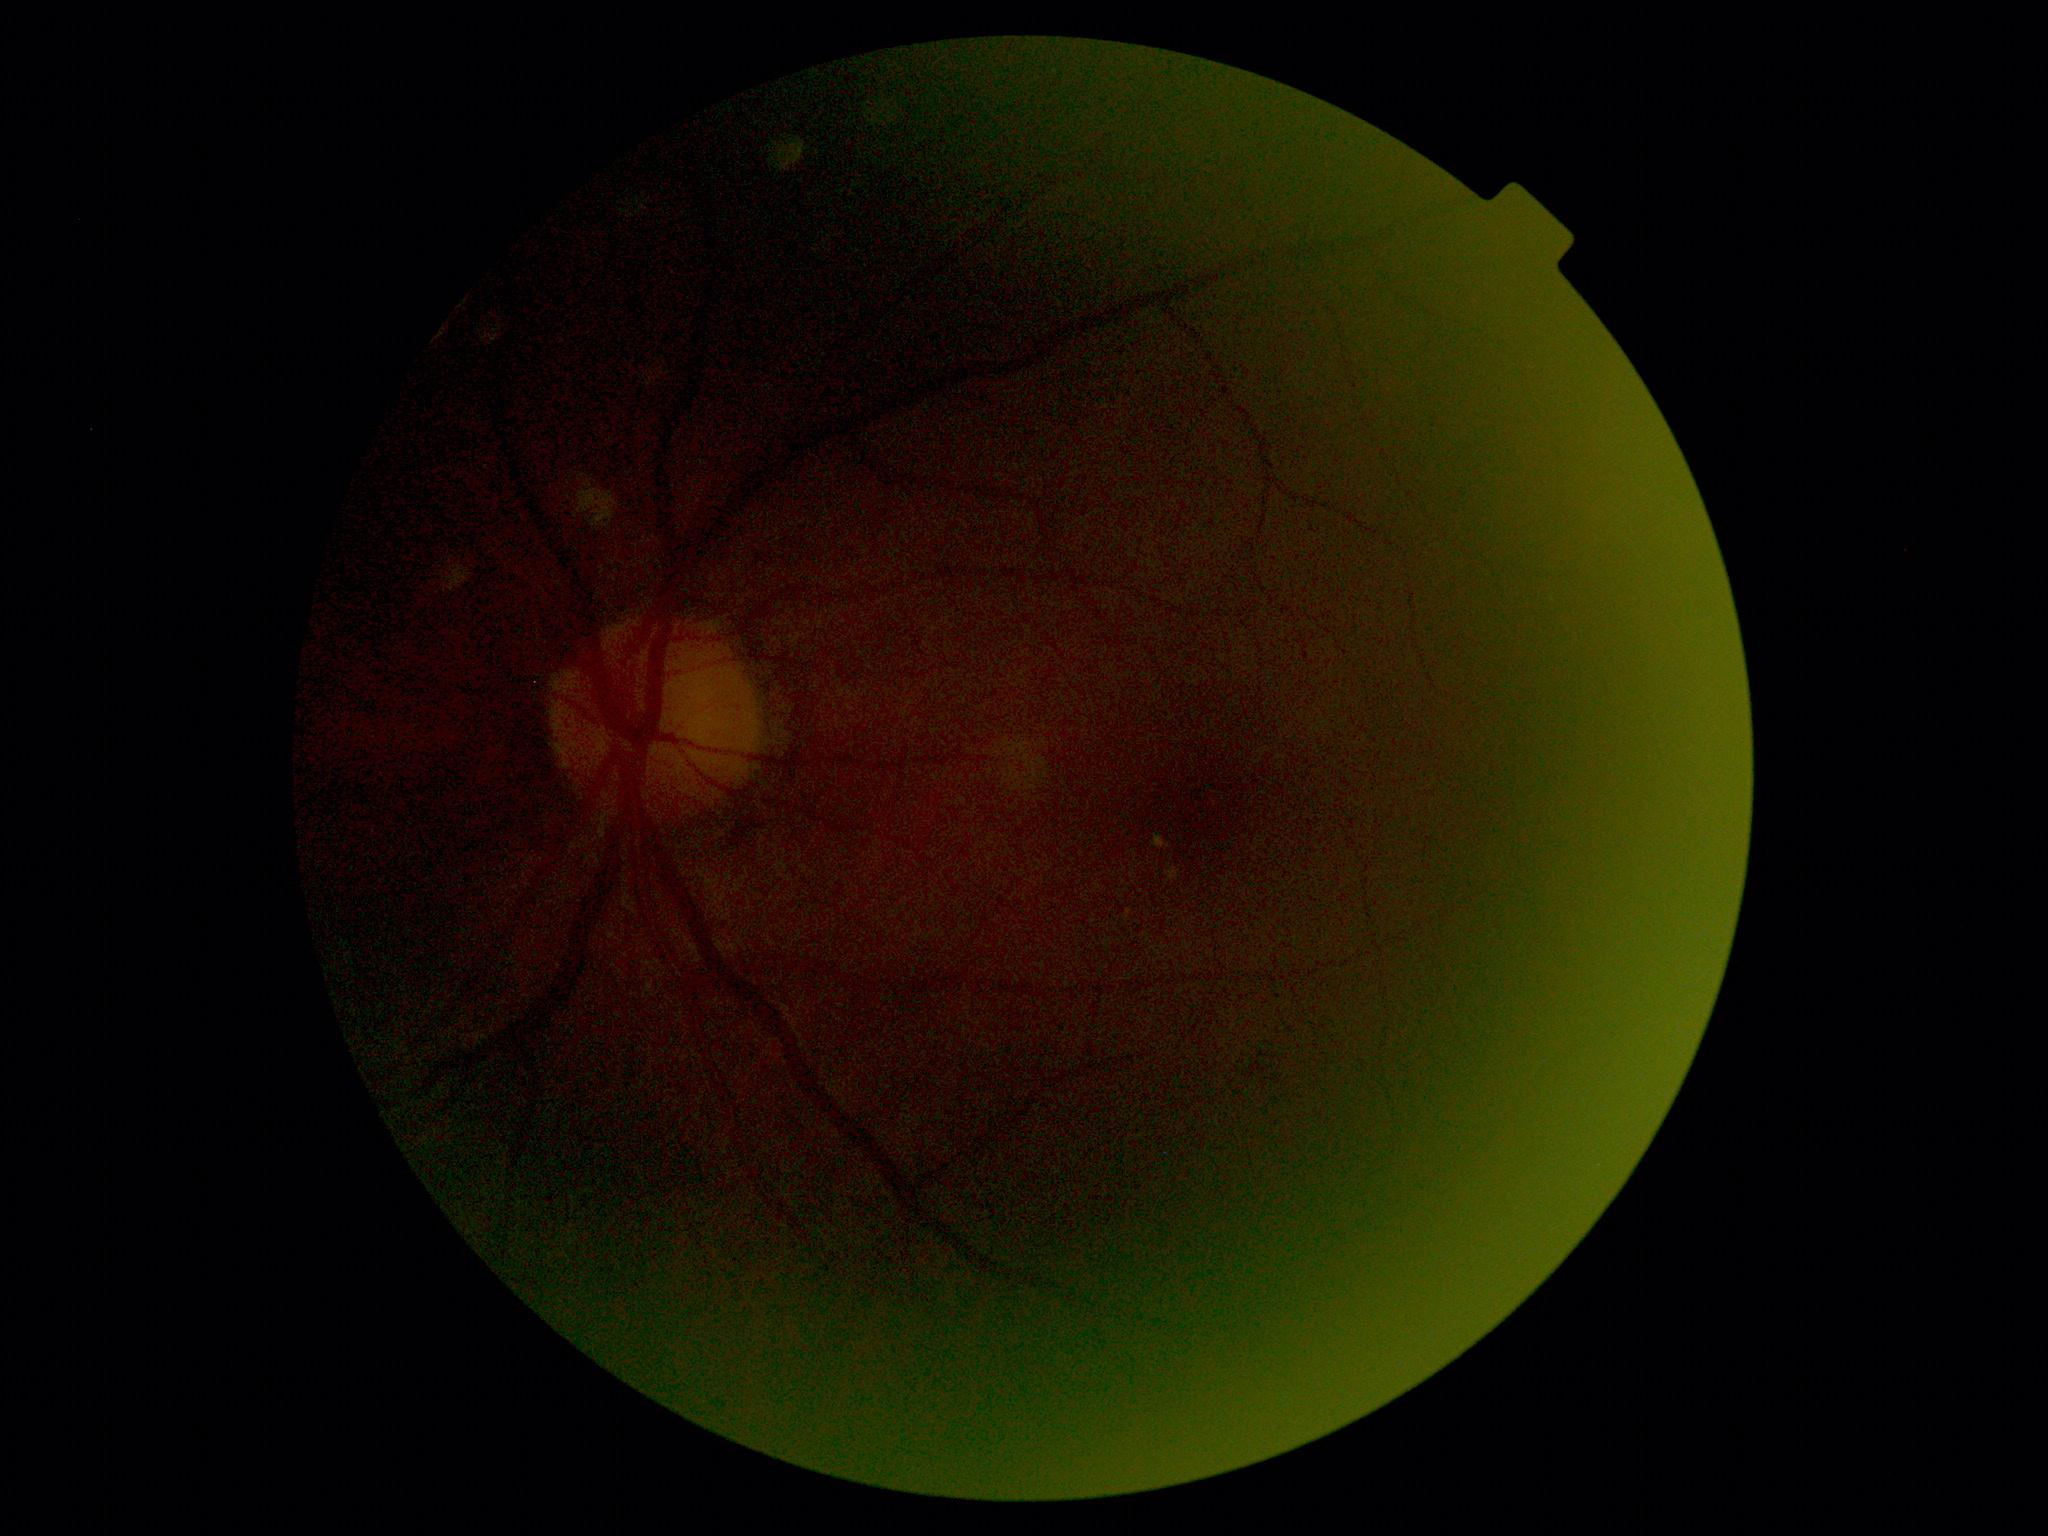   dr_grade: grade 2 (moderate NPDR) — more than just microaneurysms but less than severe NPDR